Color fundus image:
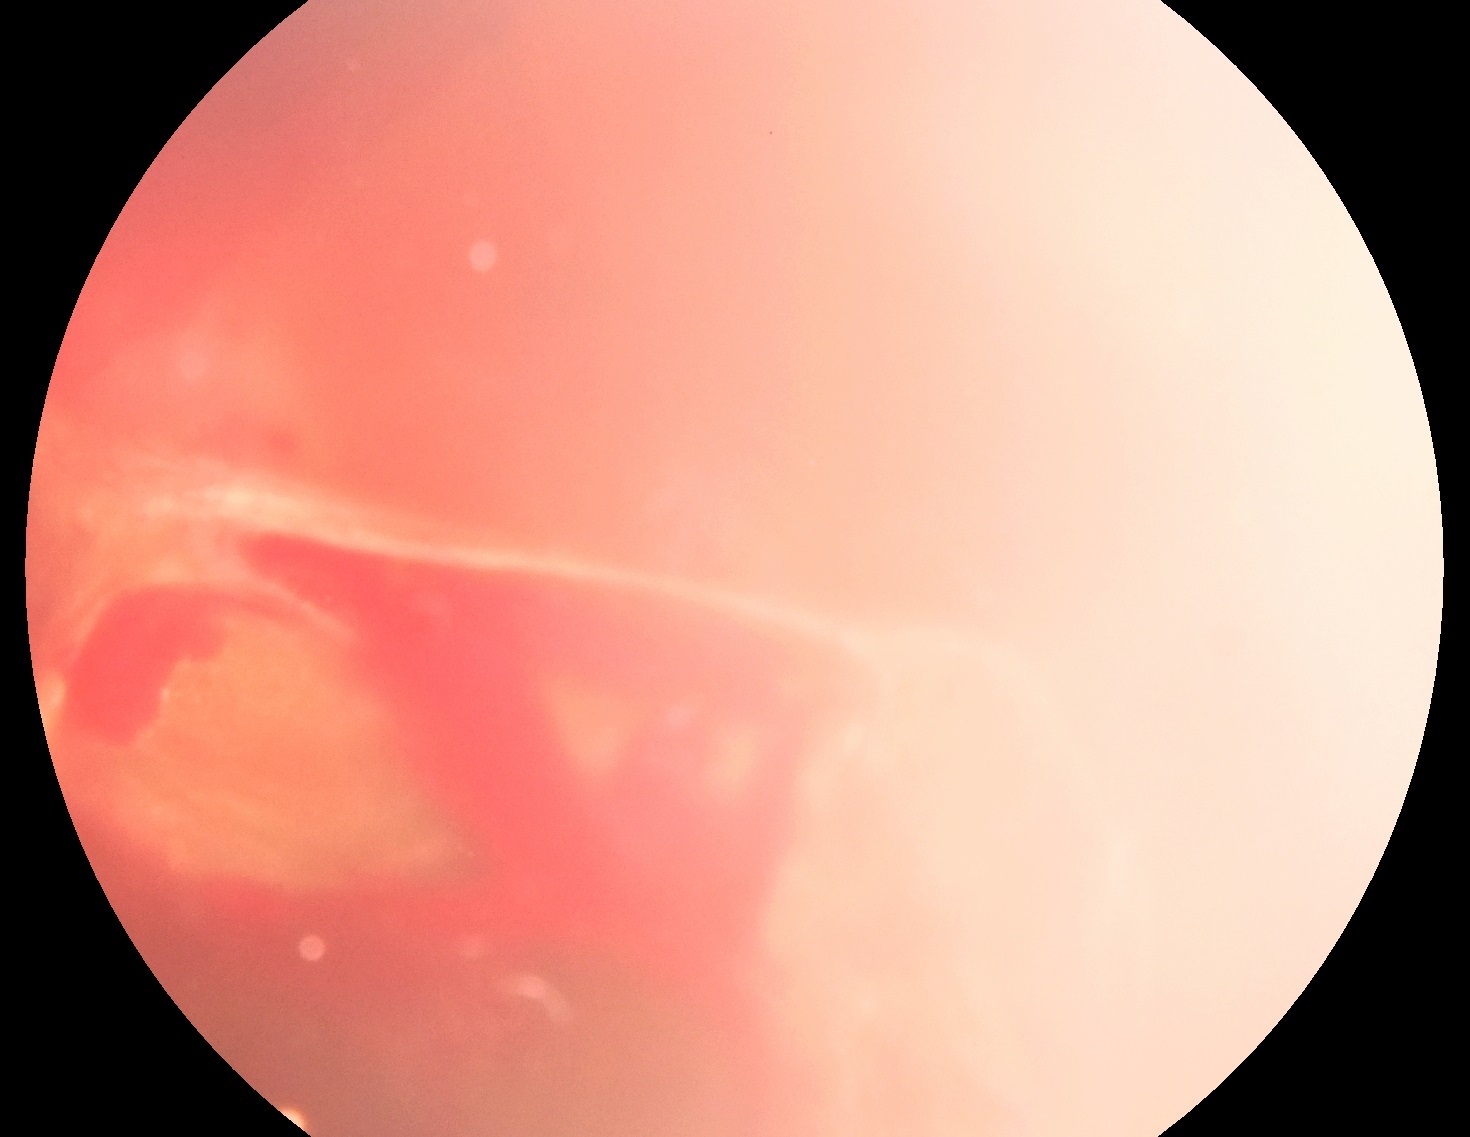
Findings:
- diabetic retinopathy severity — grade 4 (PDR)